Pediatric retinal photograph (wide-field)
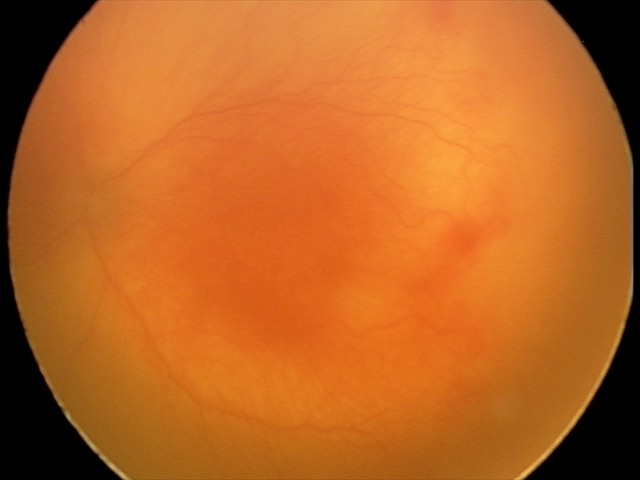
From an examination with diagnosis of aggressive ROP (A-ROP).